Infant wide-field retinal image. 1240x1240. Captured with the Phoenix ICON (100° field of view)
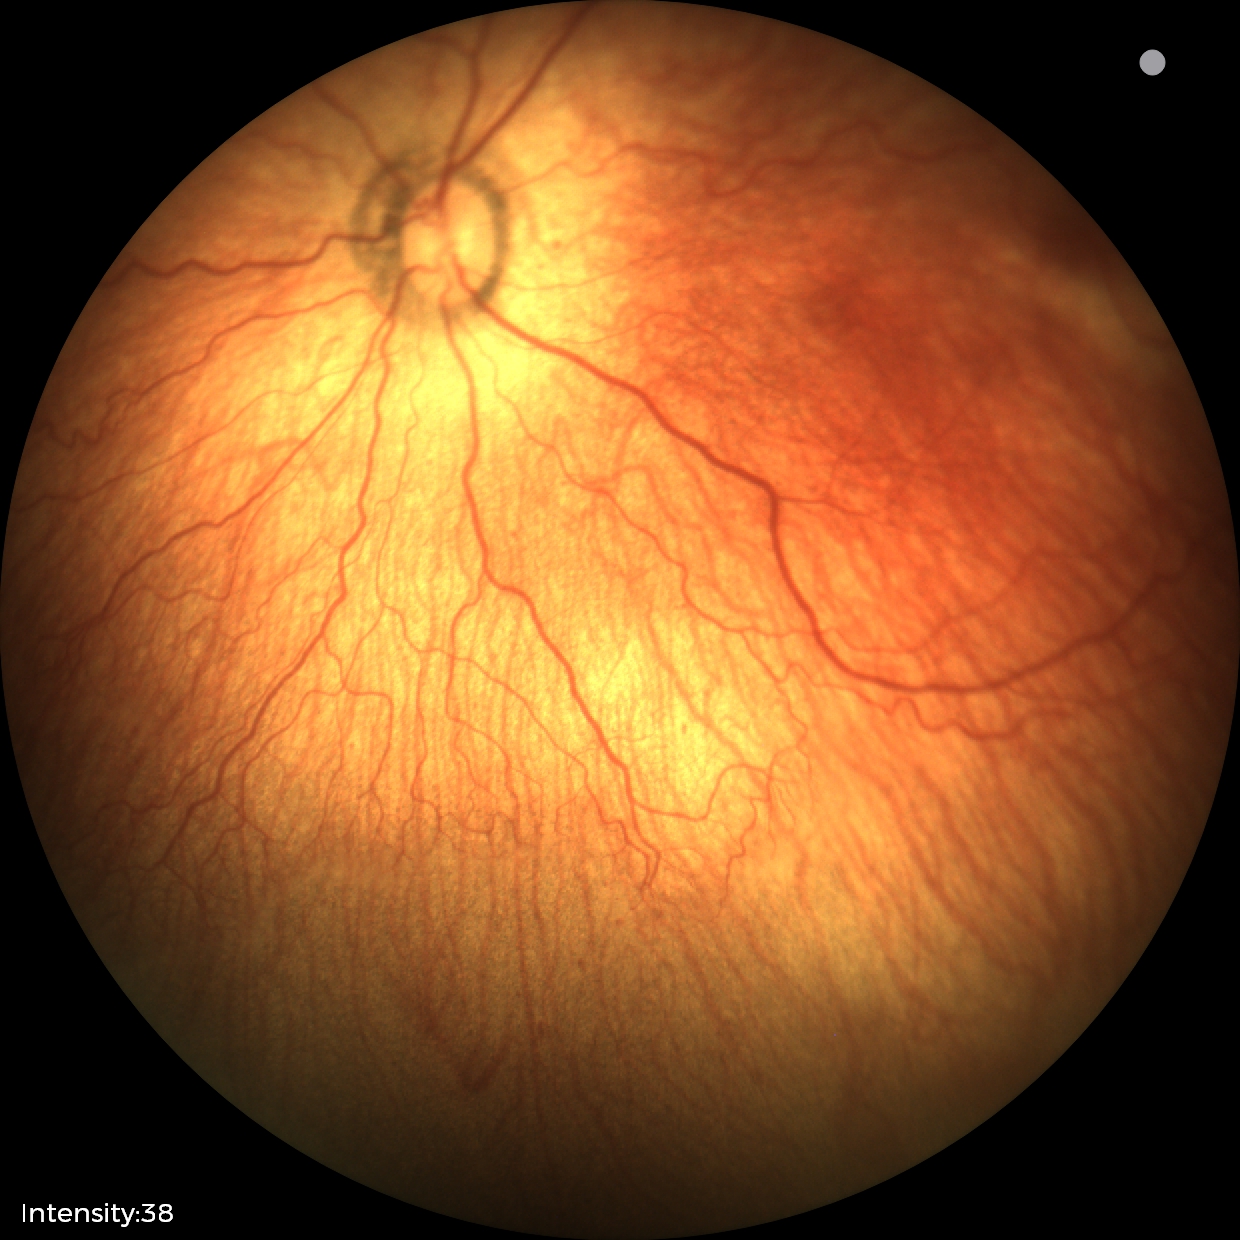 Assessment: no plus disease — posterior pole vessels without abnormal dilation or tortuosity; ROP stage 1.